Ultra-widefield fundus photograph: 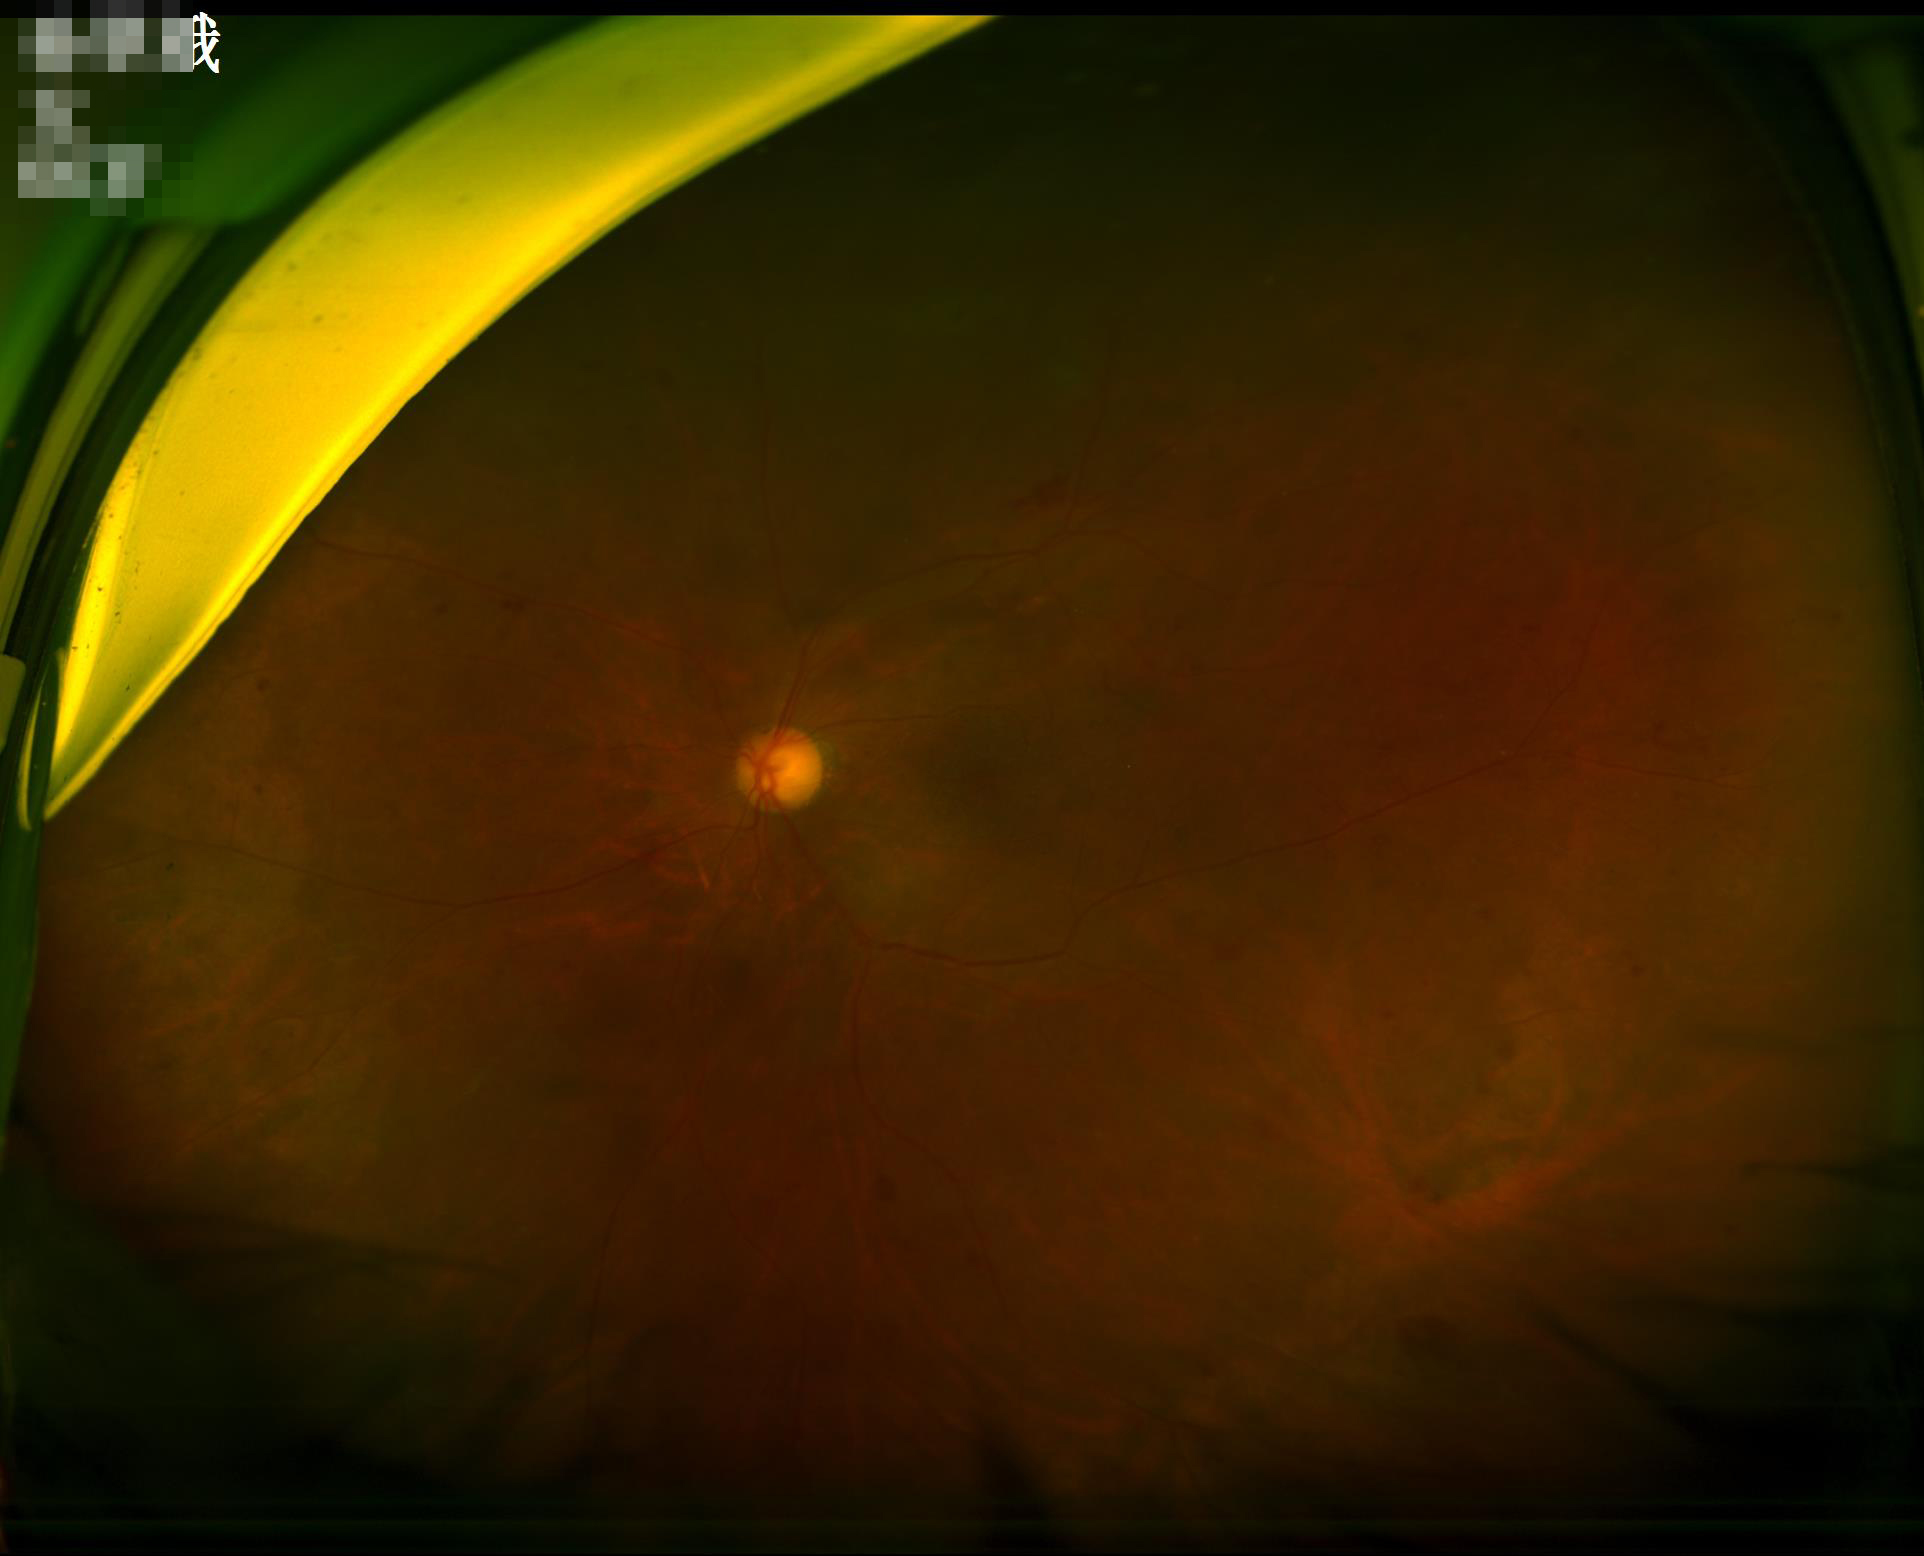 Clarity = noticeable blur in the optic disc, vessels, or background | Overall image quality = inadequate for clinical interpretation | Illumination/color = inadequate, with uneven exposure or color distortion.